1240 by 1240 pixels; infant wide-field retinal image; acquired on the Phoenix ICON:
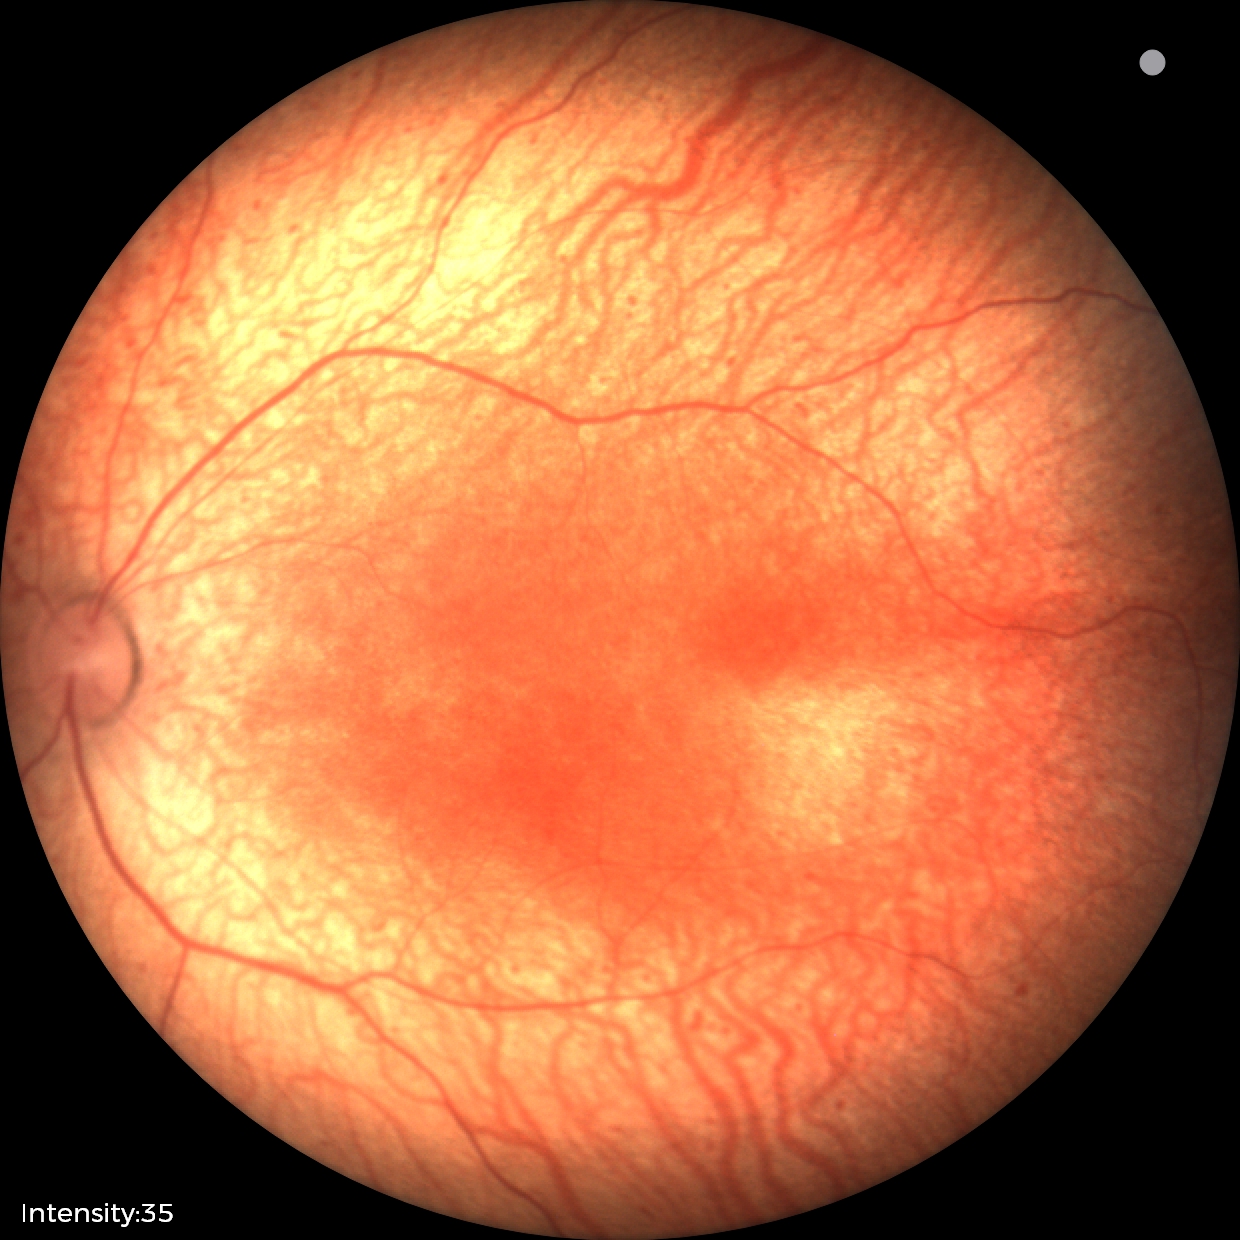
From an examination with diagnosis of status post ROP — retinal appearance after treated retinopathy of prematurity.